45-degree field of view. CFP — 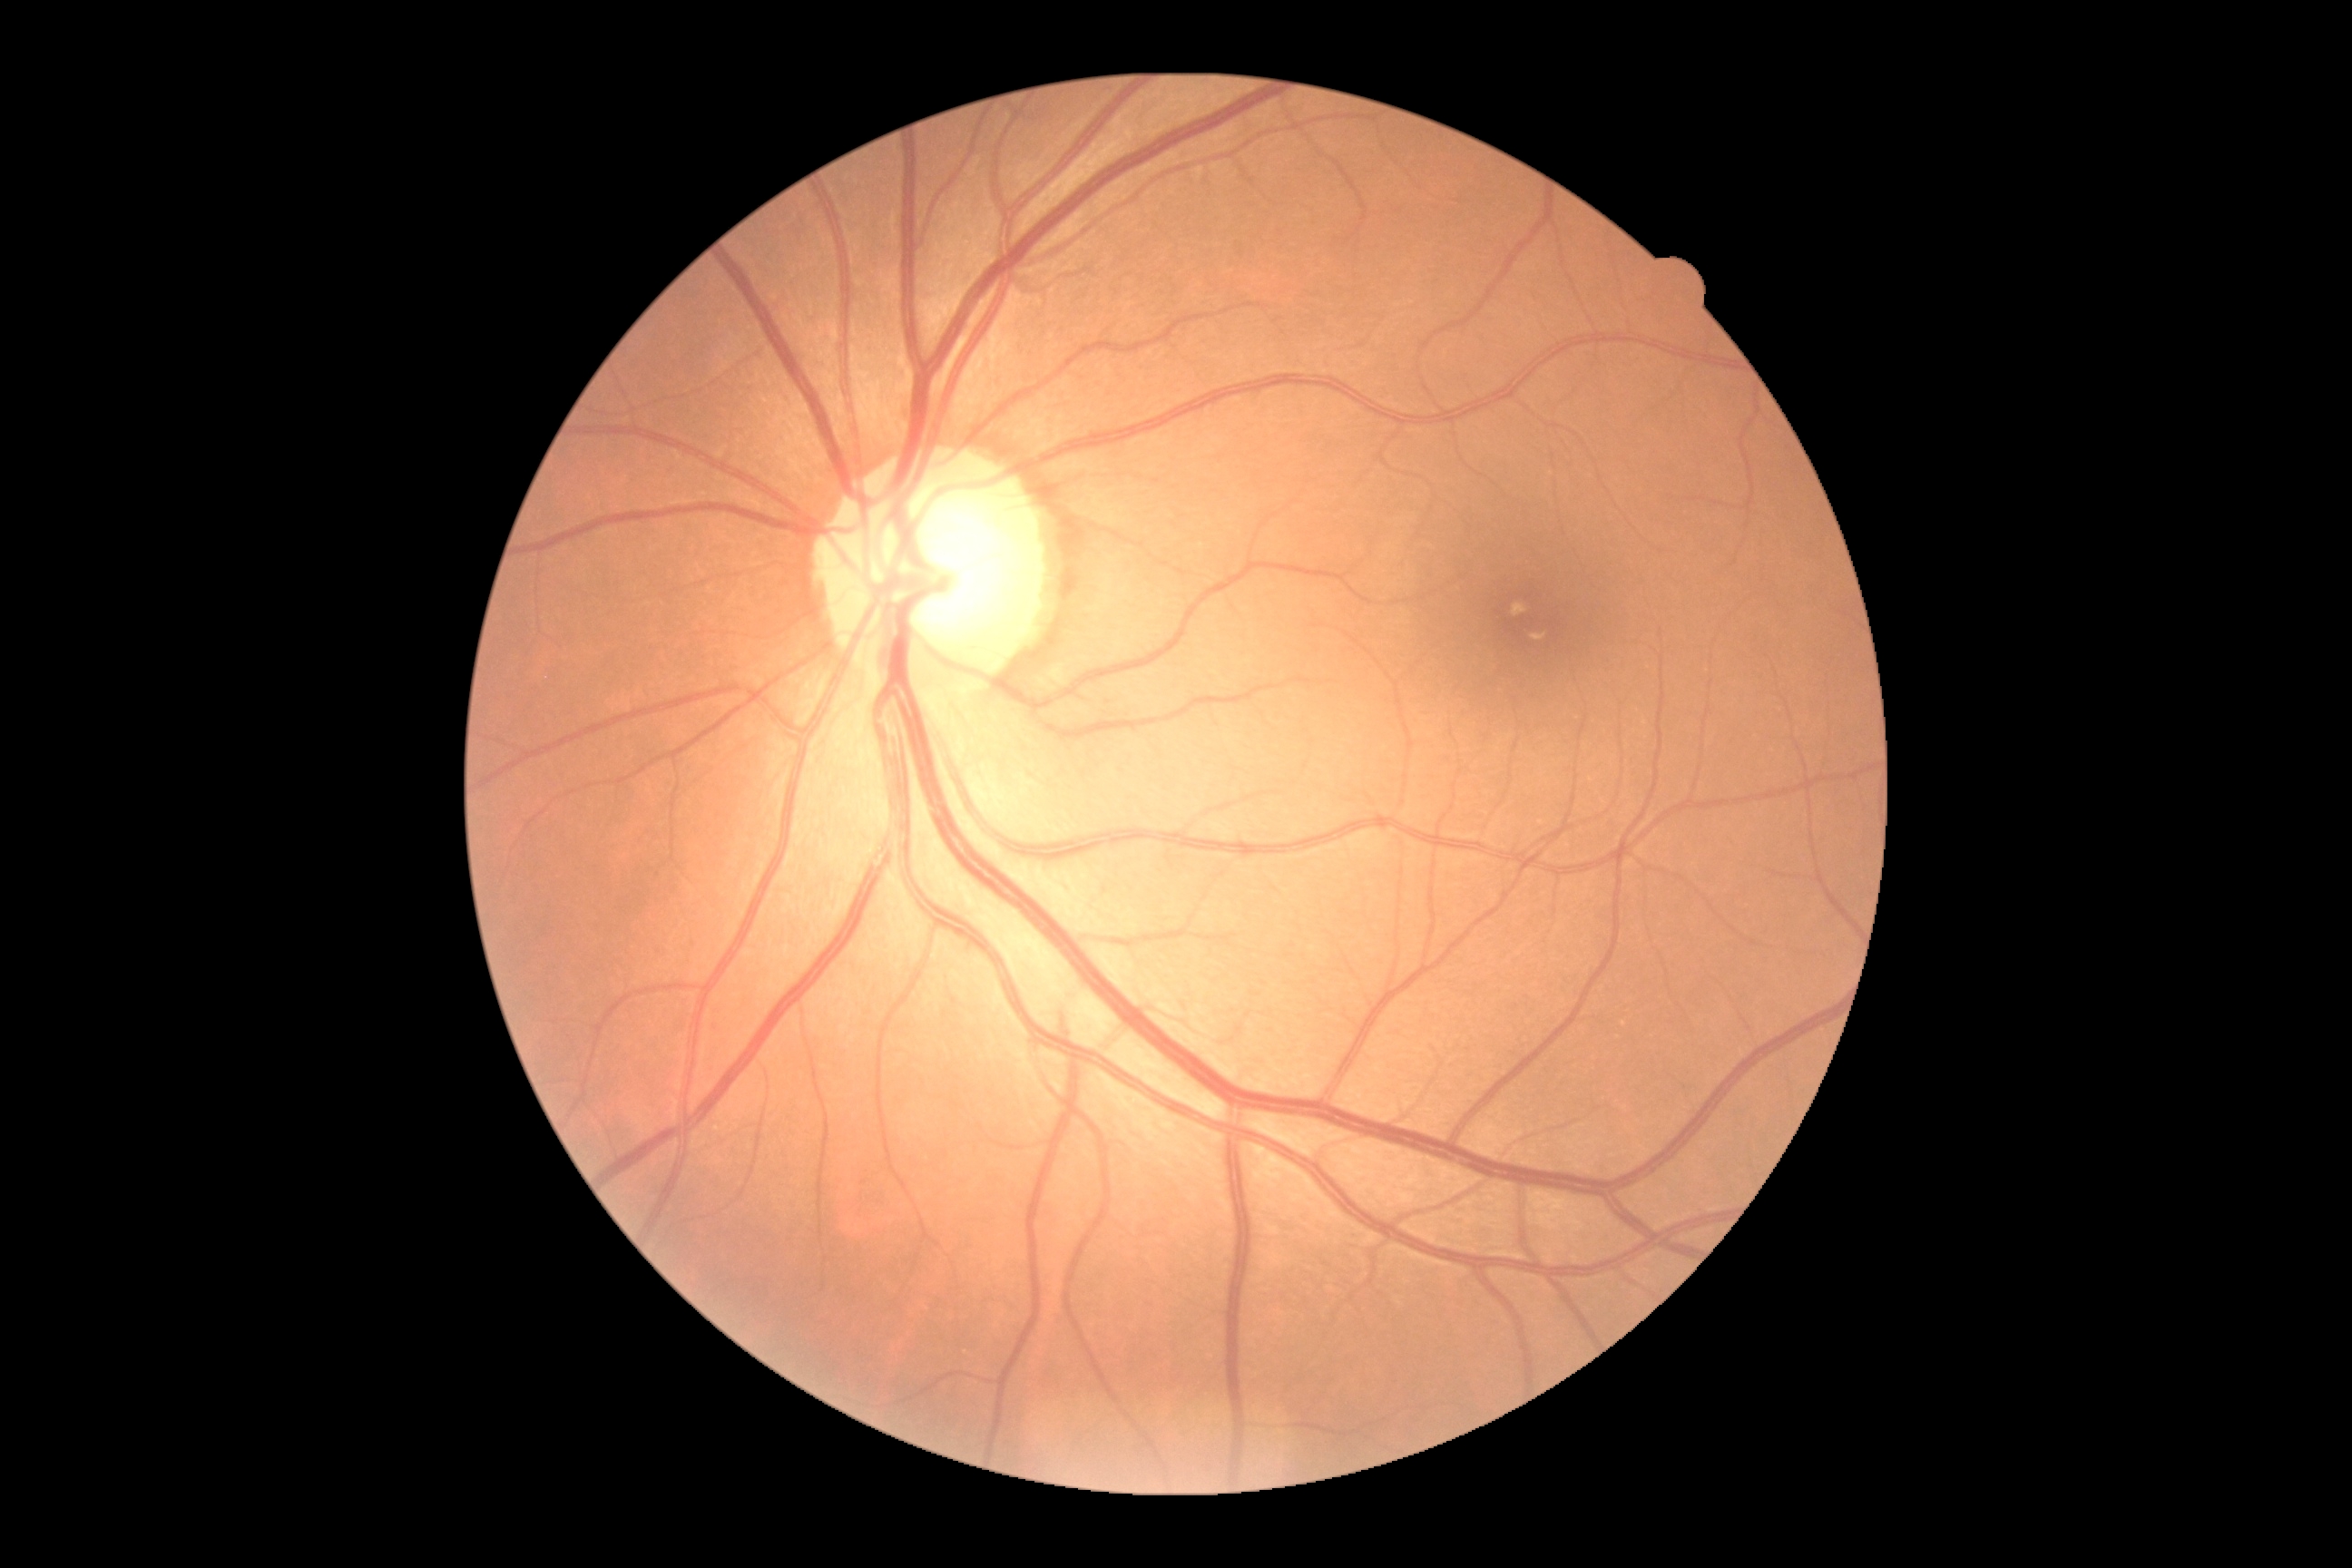
• diabetic retinopathy grade — 0/4
• DR impression — no signs of DR